Captured with the Phoenix ICON (100° field of view); infant wide-field retinal image
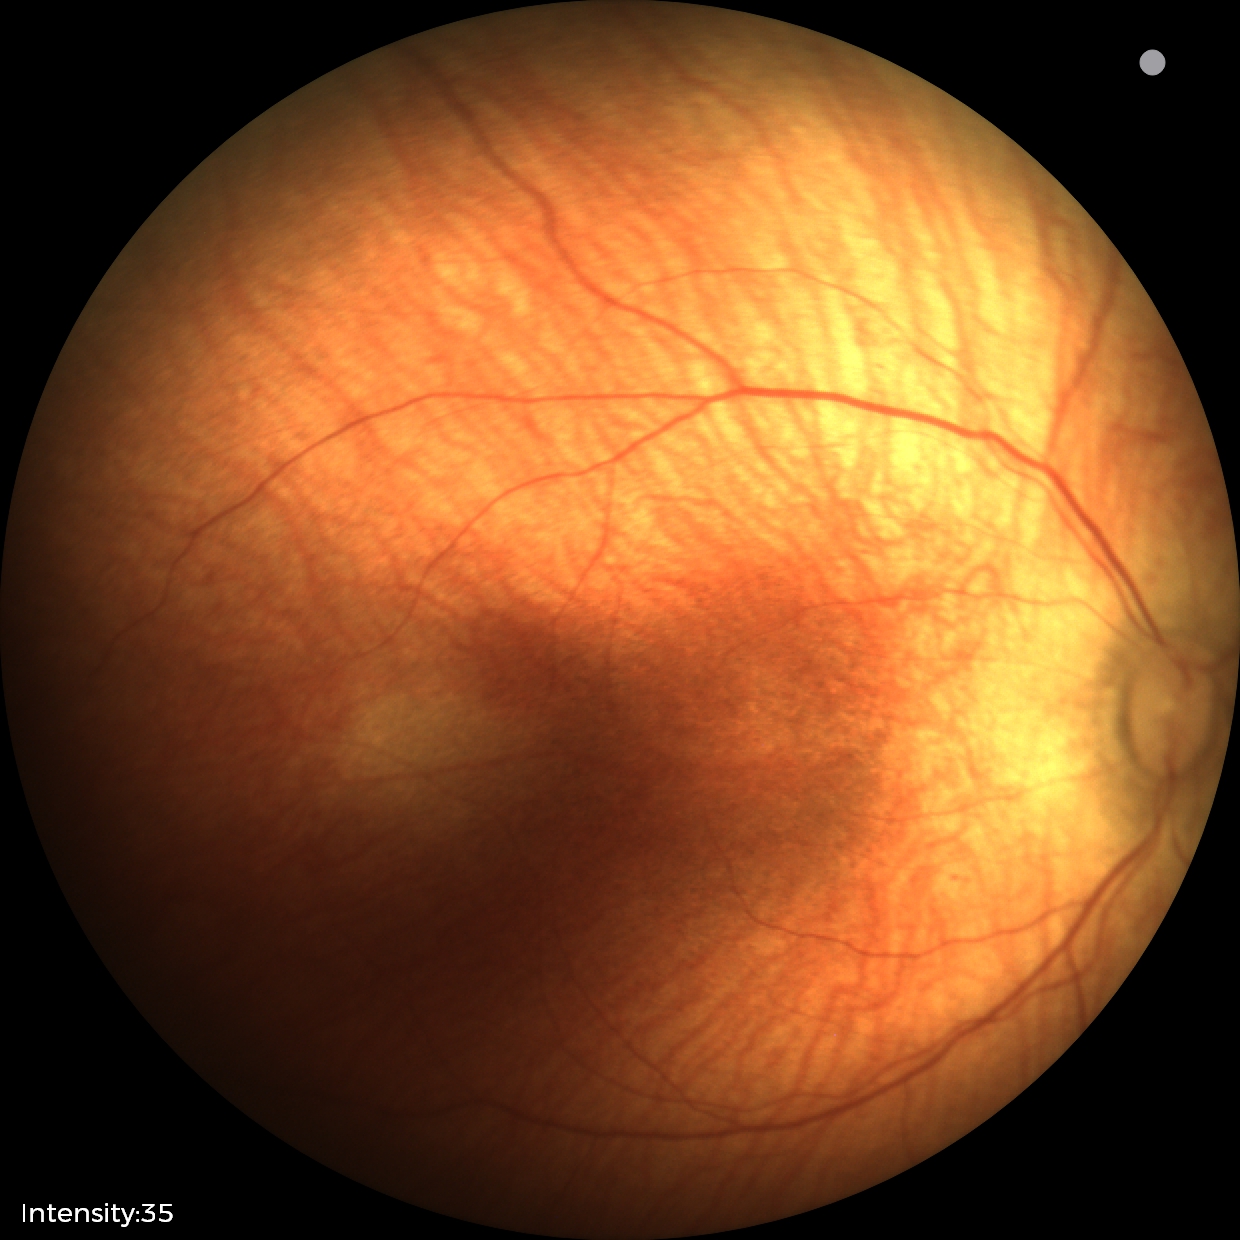
Assessment: status post ROP | no plus disease.